Wide-field fundus photograph from neonatal ROP screening
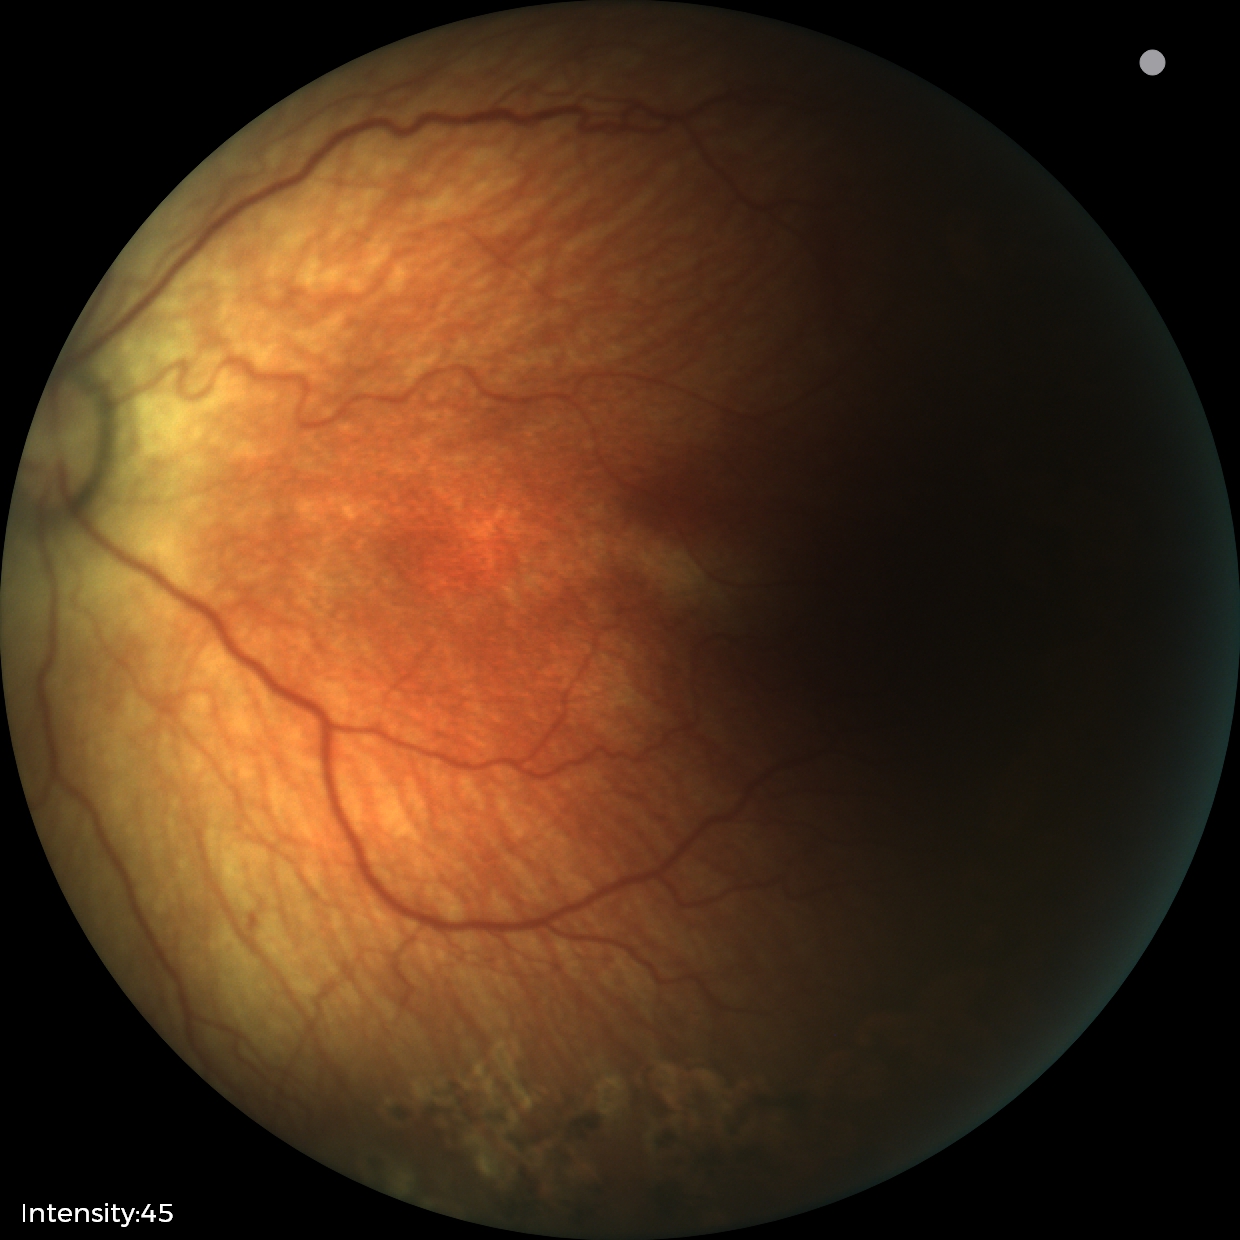
Plus disease = absent; screening diagnosis = status post ROP.